FOV: 45 degrees; color fundus photograph
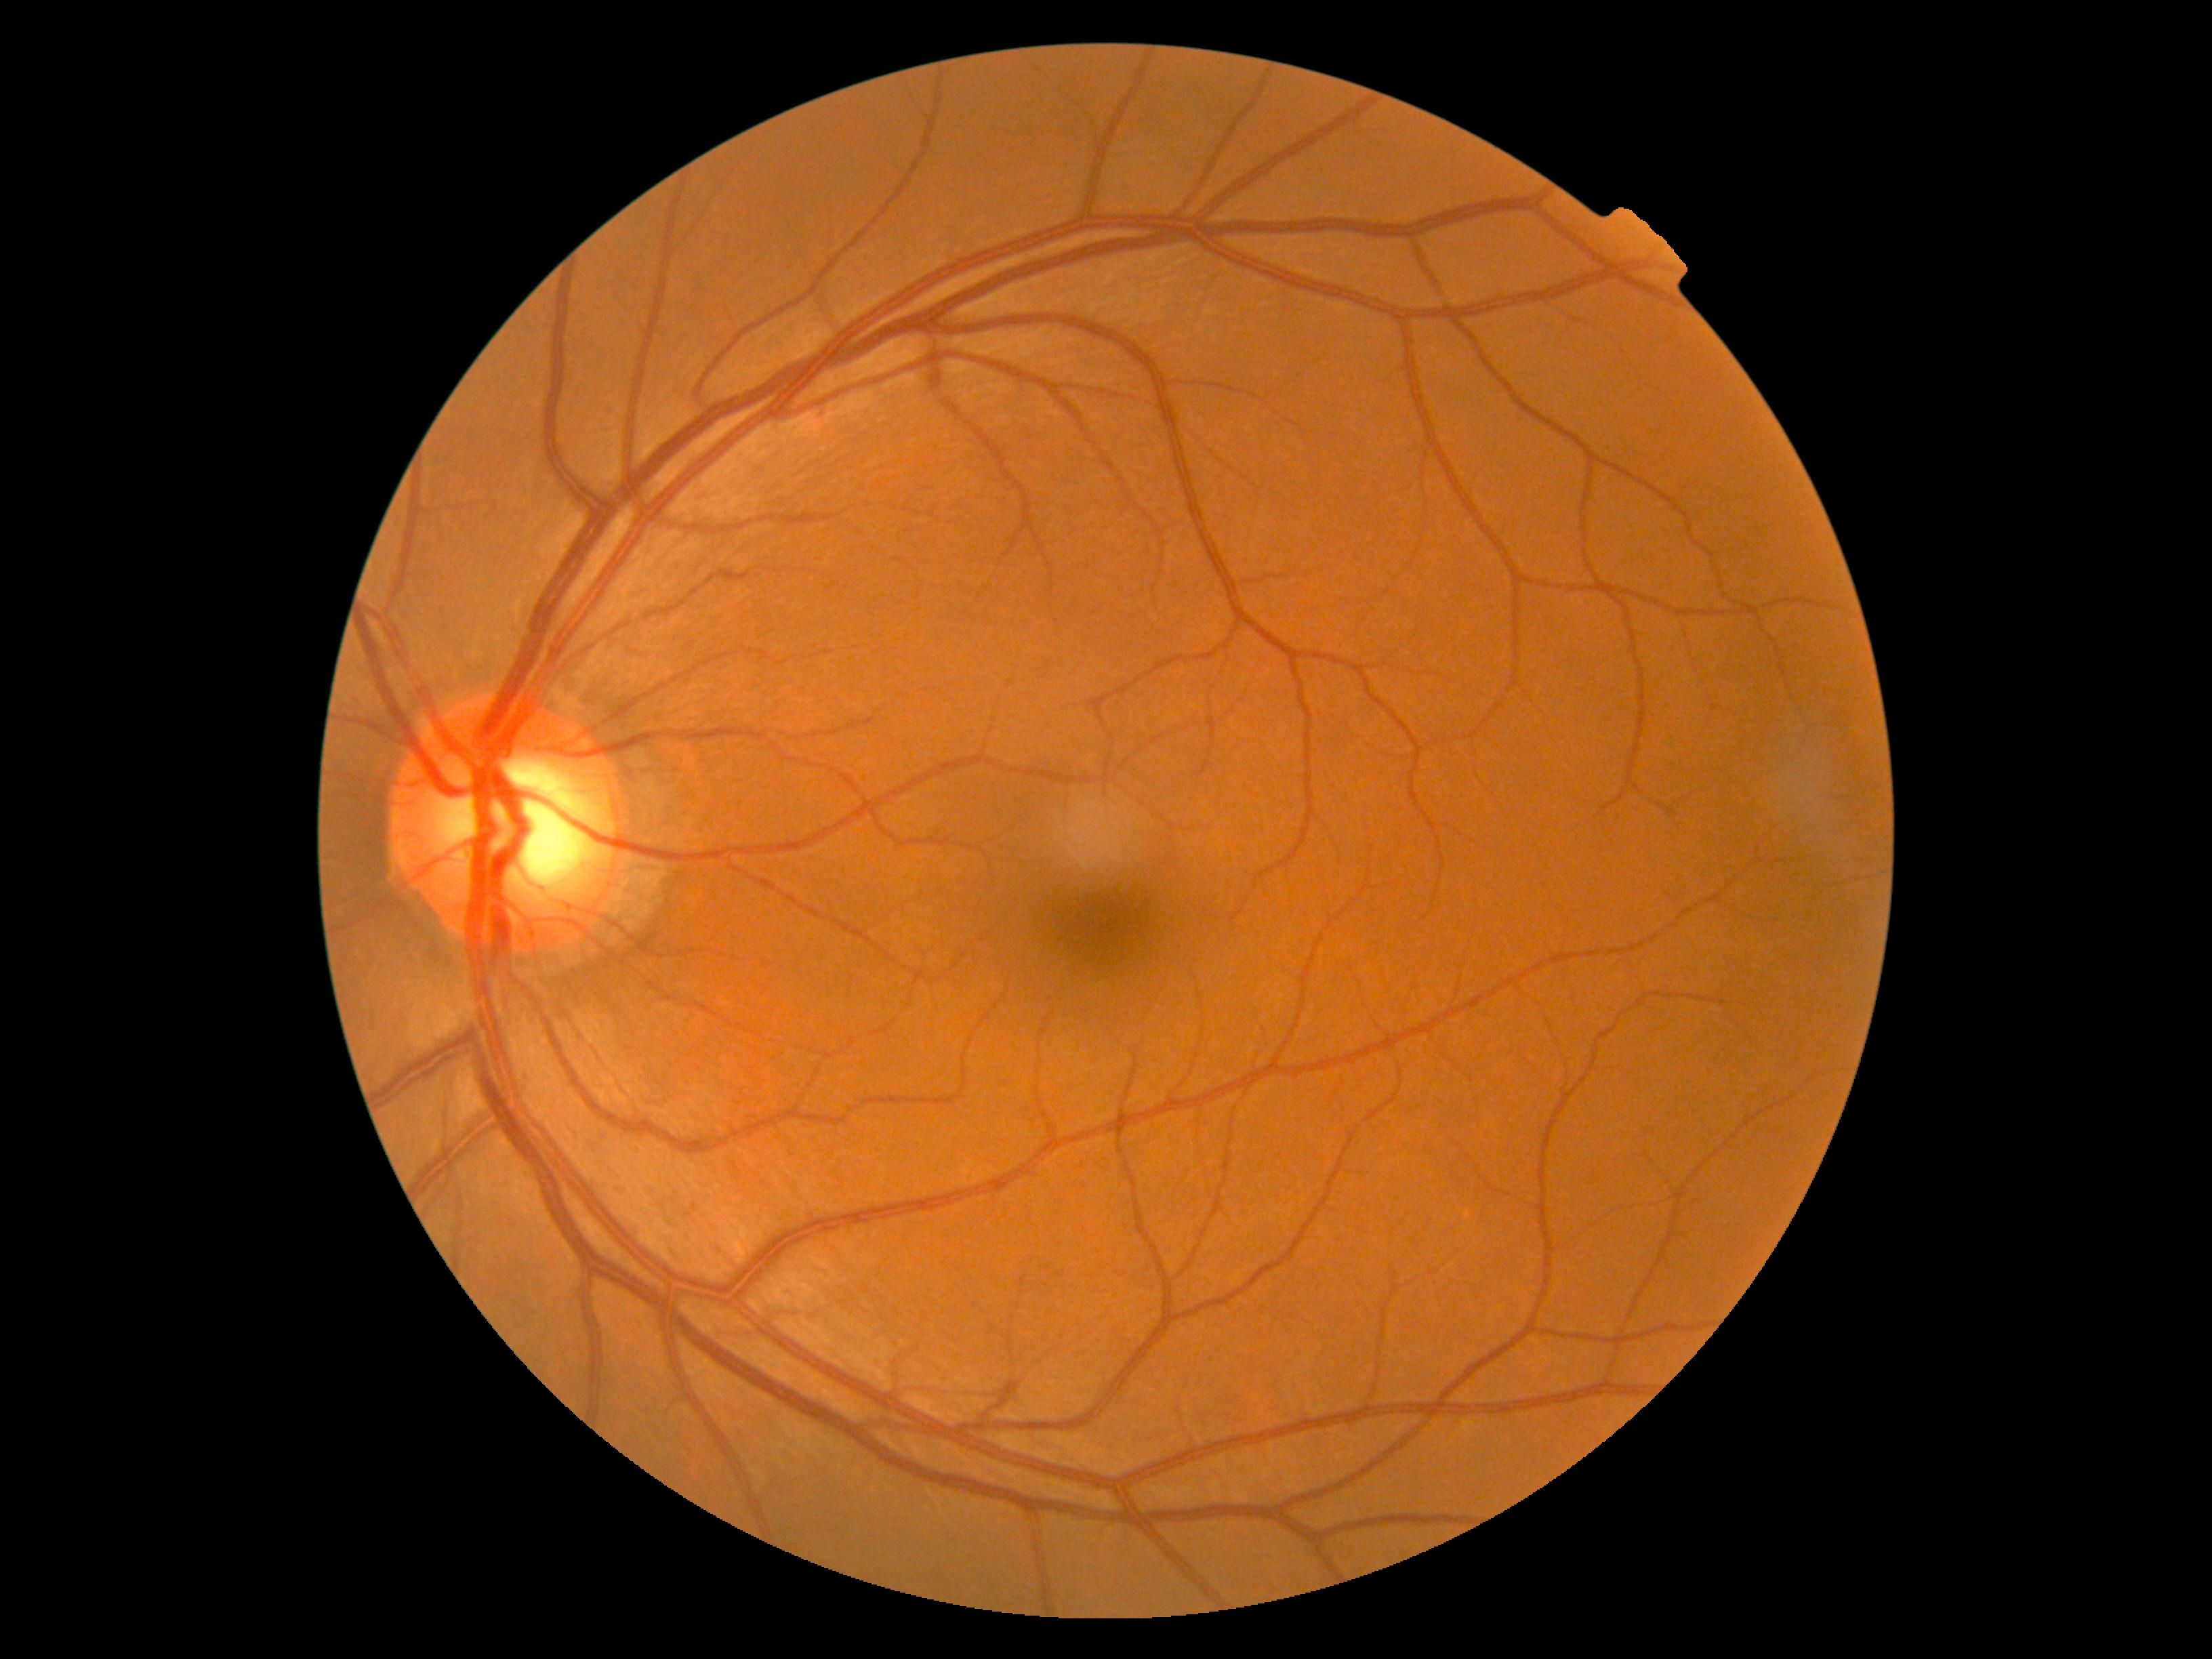
No apparent diabetic retinopathy. DR grade: 0/4.